2102 x 1736 pixels.
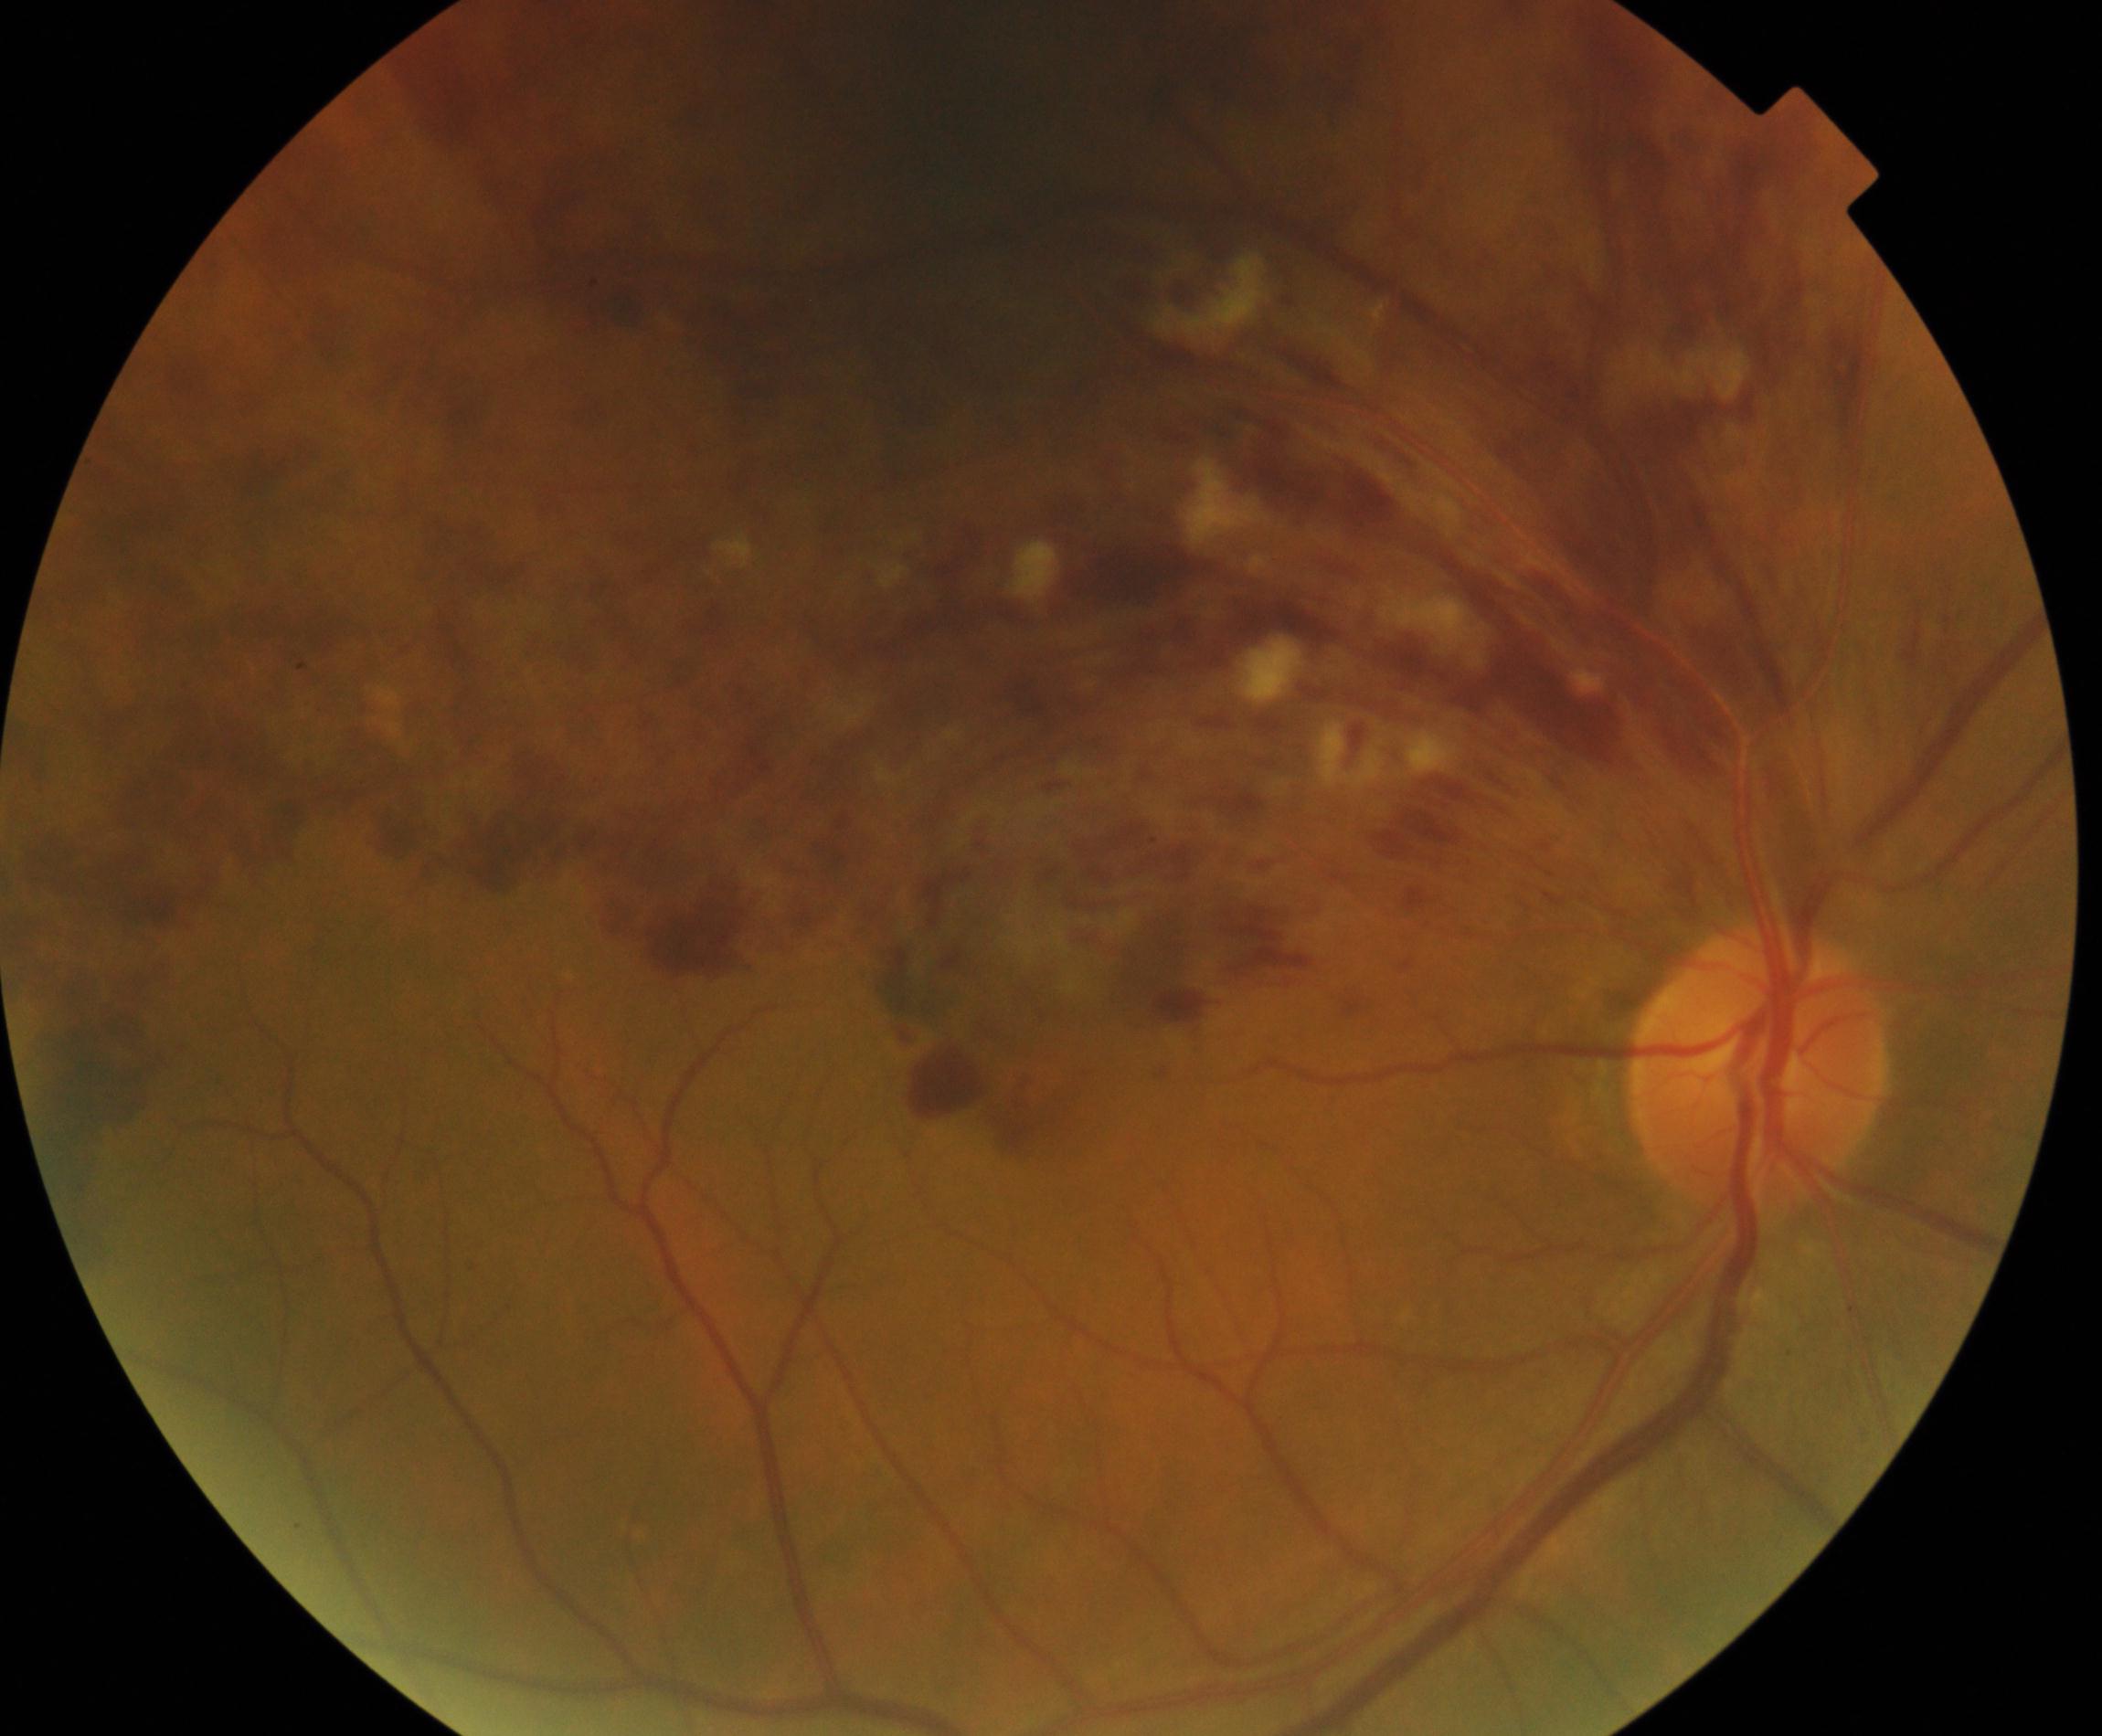 The image shows BRVO (branch retinal vein occlusion).